Image size 848x848
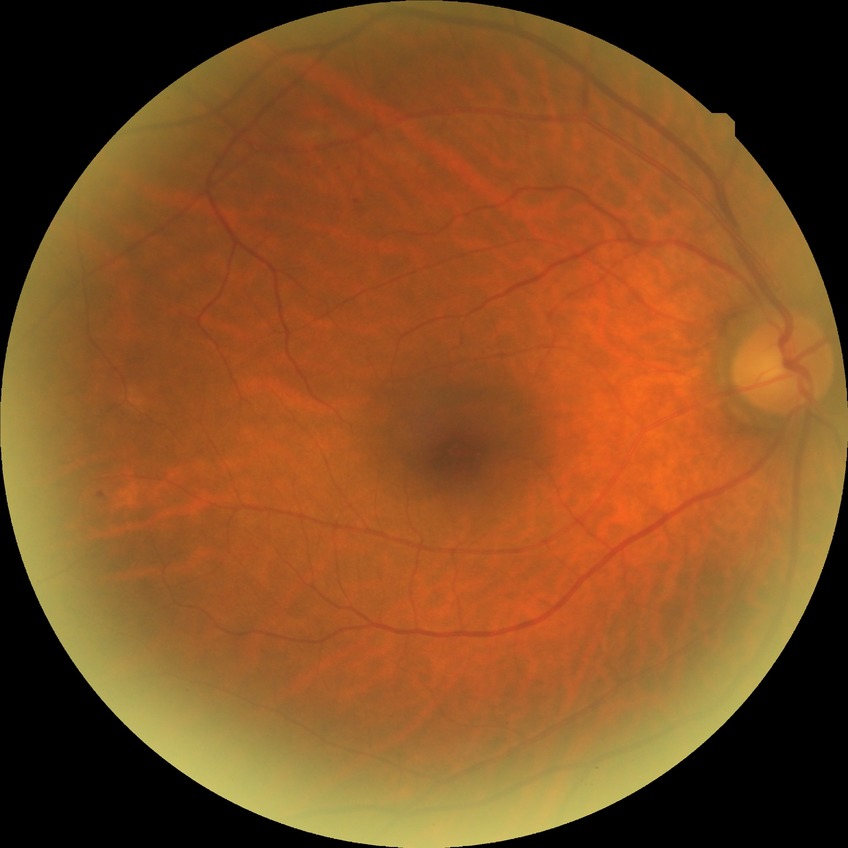 Retinopathy stage: simple diabetic retinopathy. The retinopathy is classified as non-proliferative diabetic retinopathy.